45° FOV: 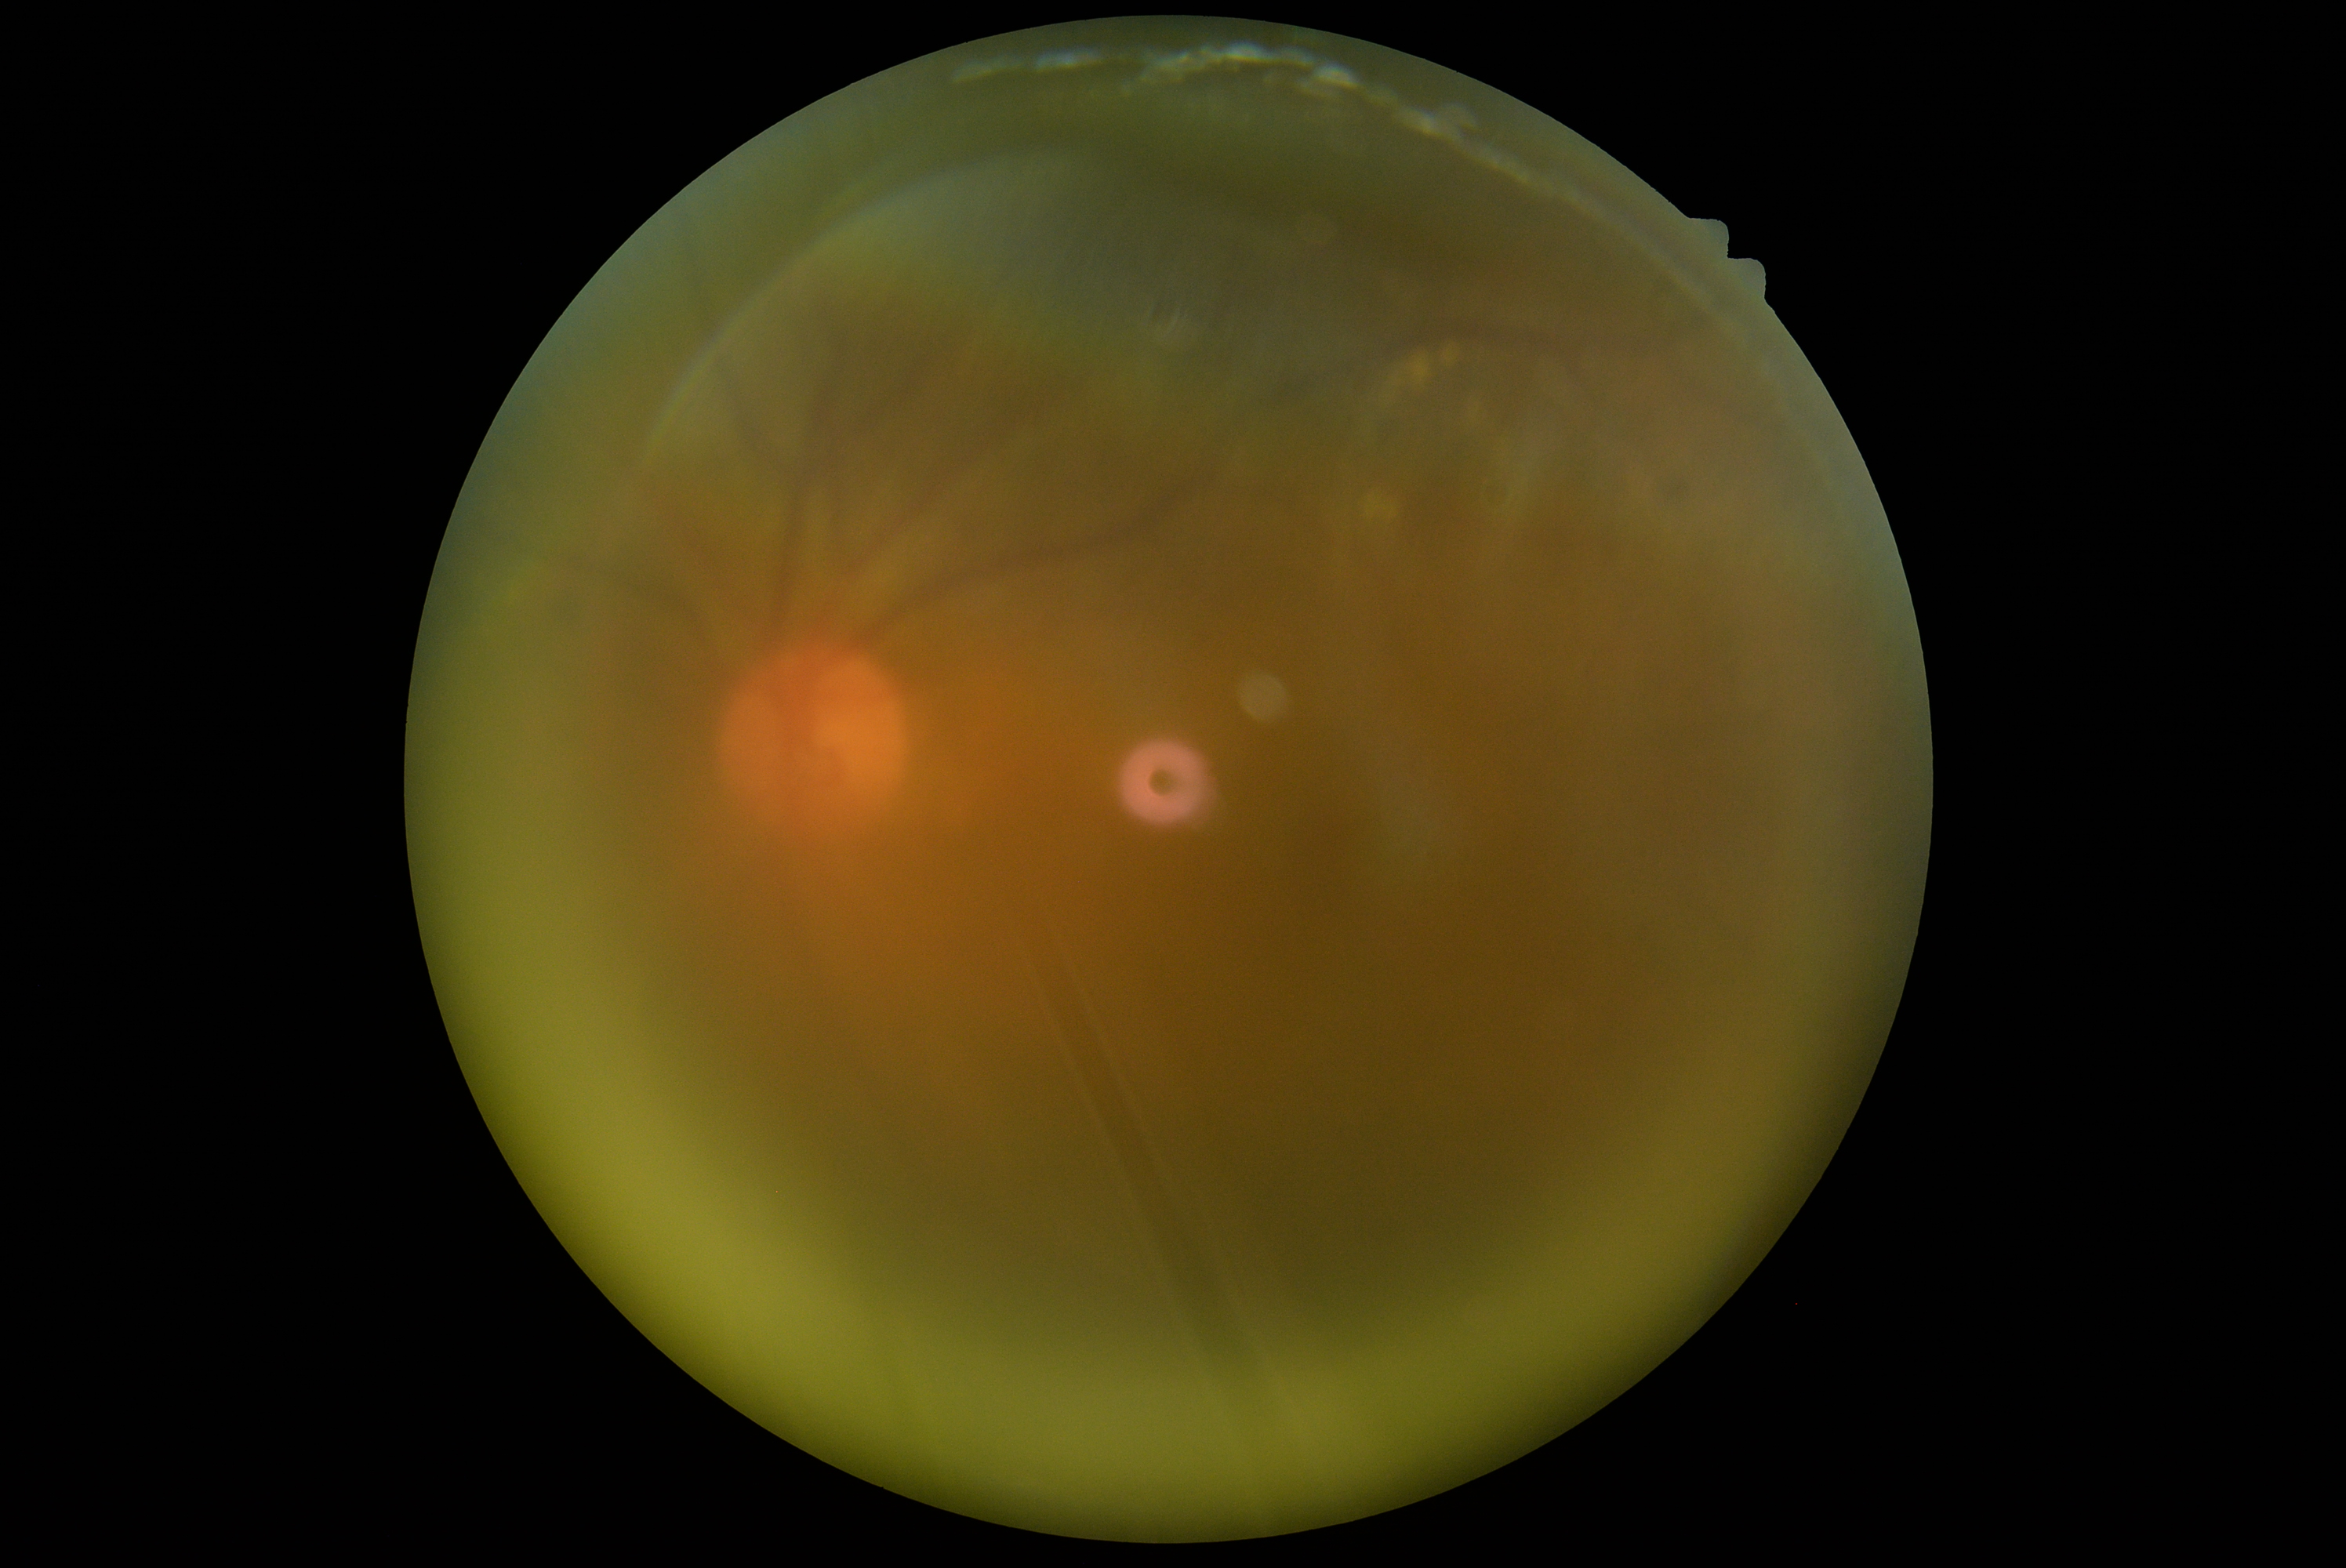 Diabetic retinopathy (DR): grade 2 (moderate NPDR).